2228 by 1652 pixels; 50-degree field of view
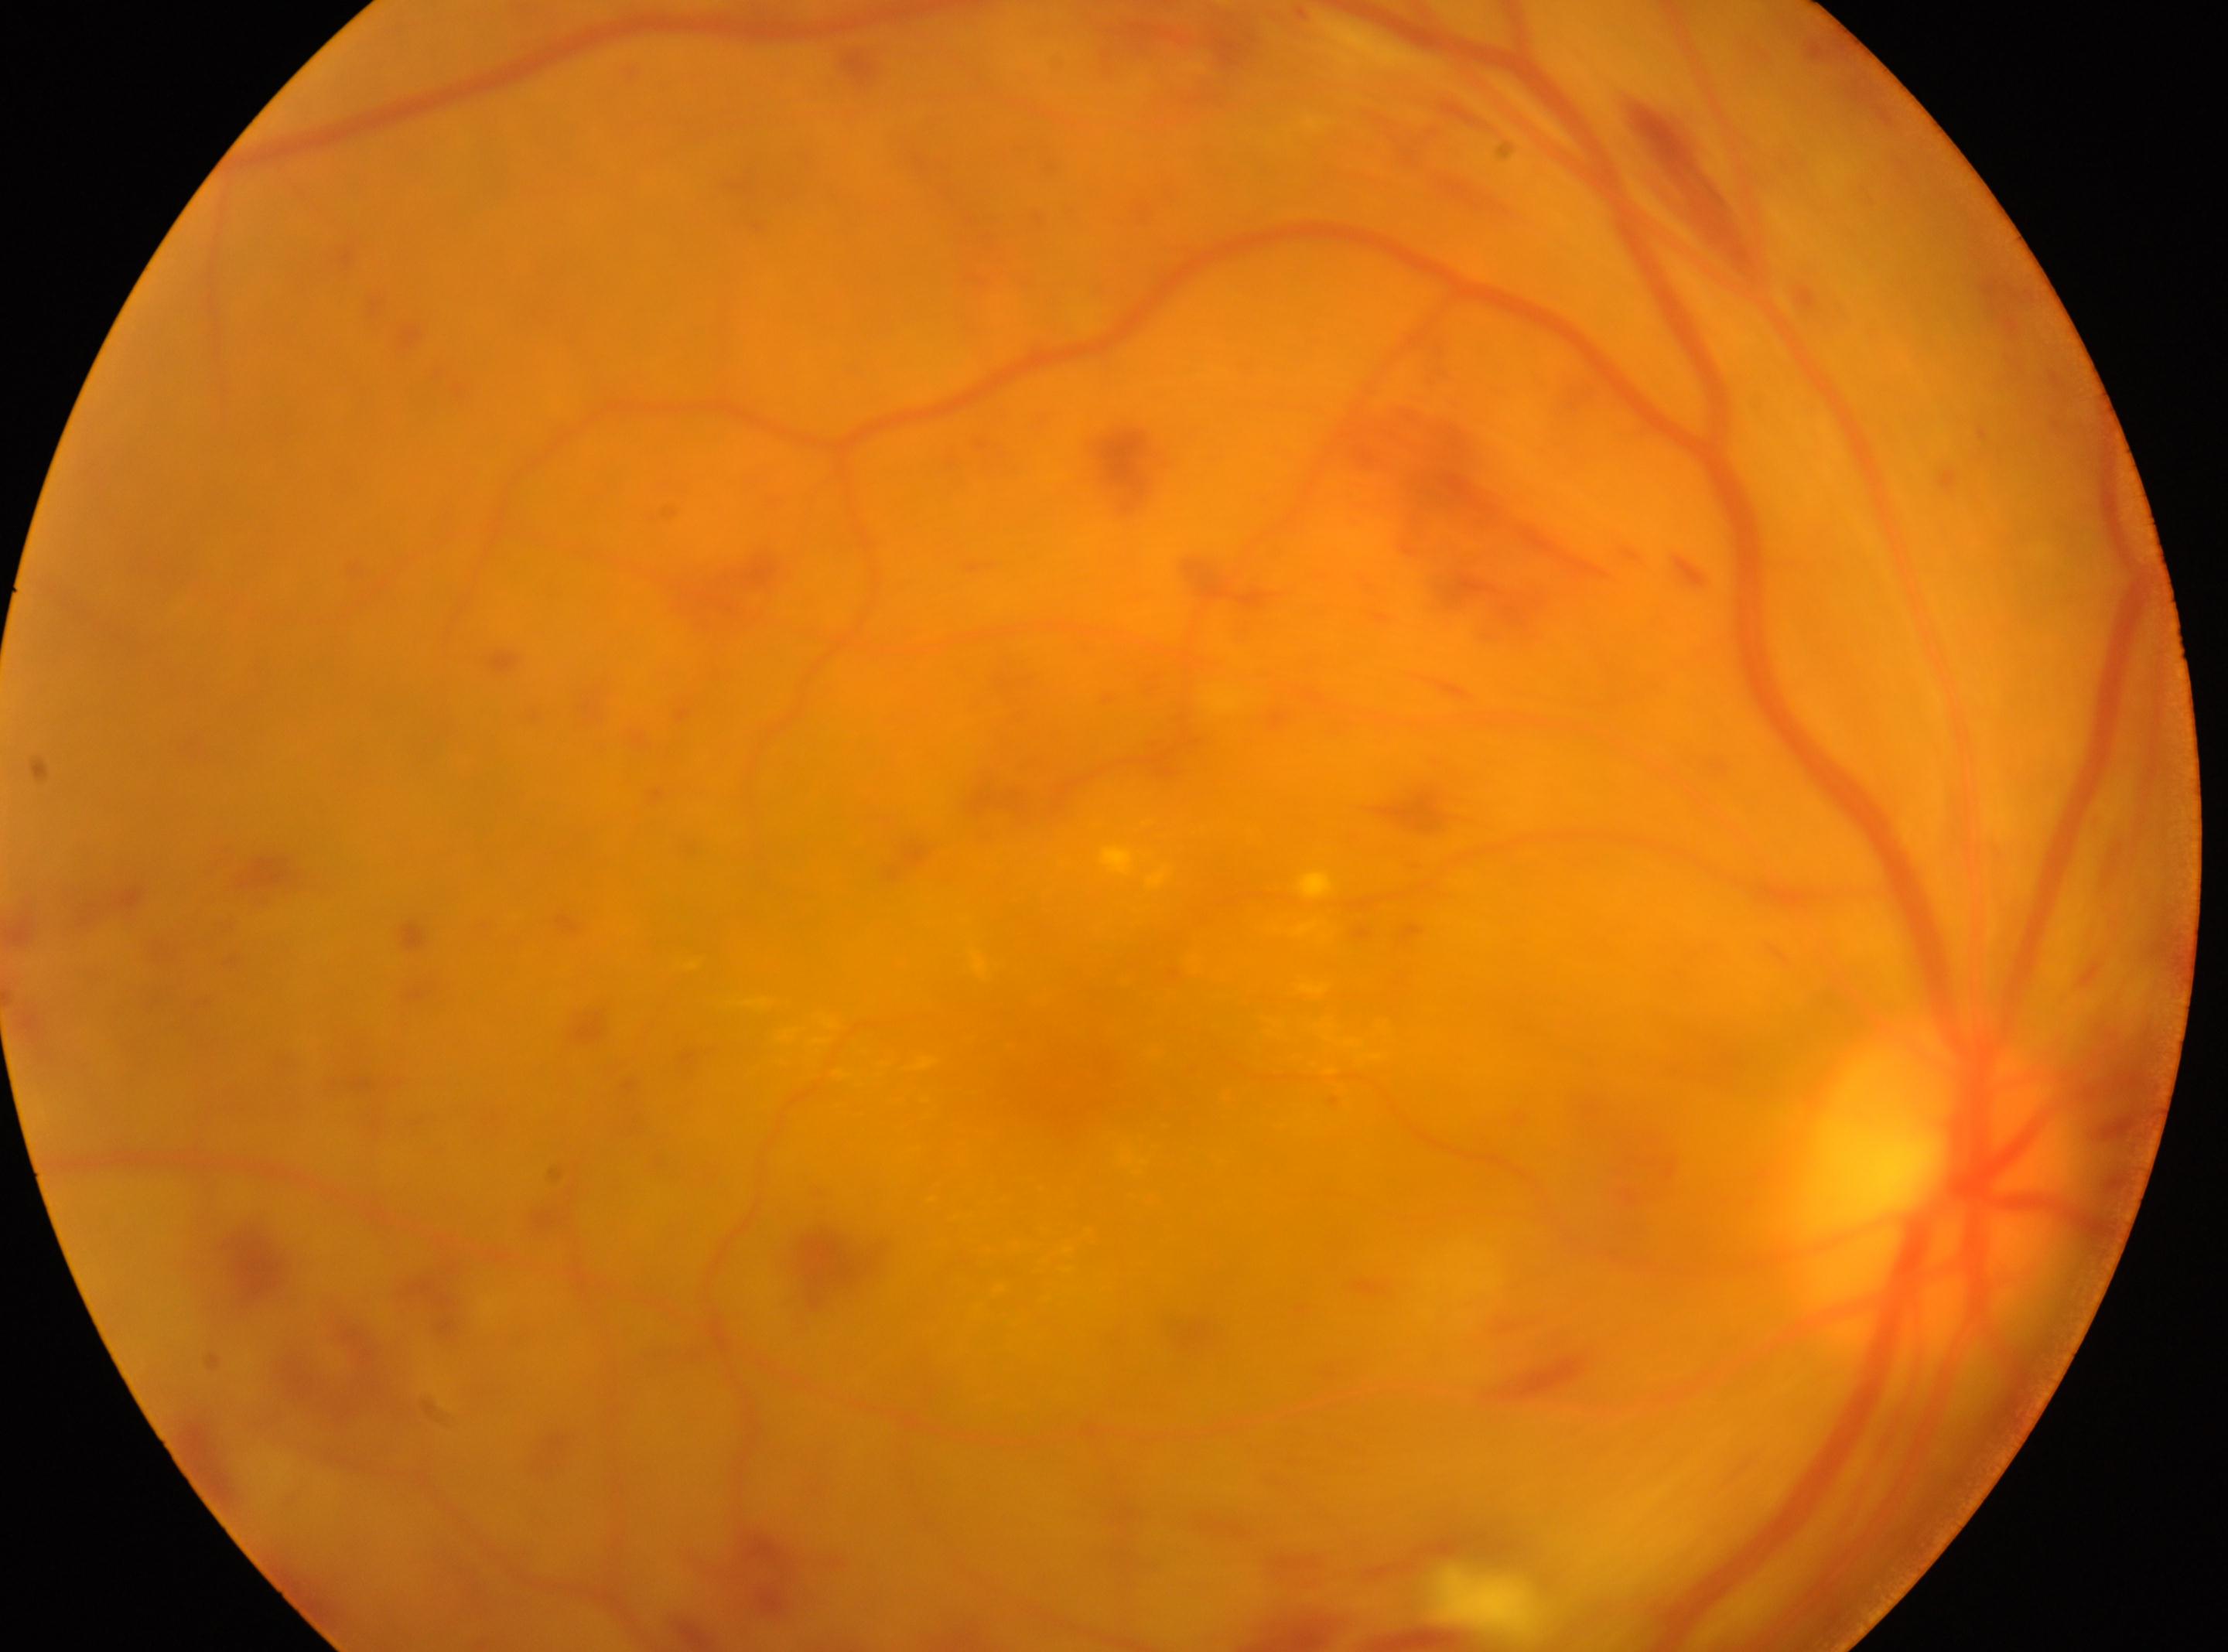
The ONH is at 1932px, 1194px. DR stage: 3/4. The retinopathy is classified as non-proliferative diabetic retinopathy. Imaged eye: oculus dexter. Fovea centralis: 1061px, 1060px.